FOV: 45 degrees; image size 2048x1536; retinal fundus photograph
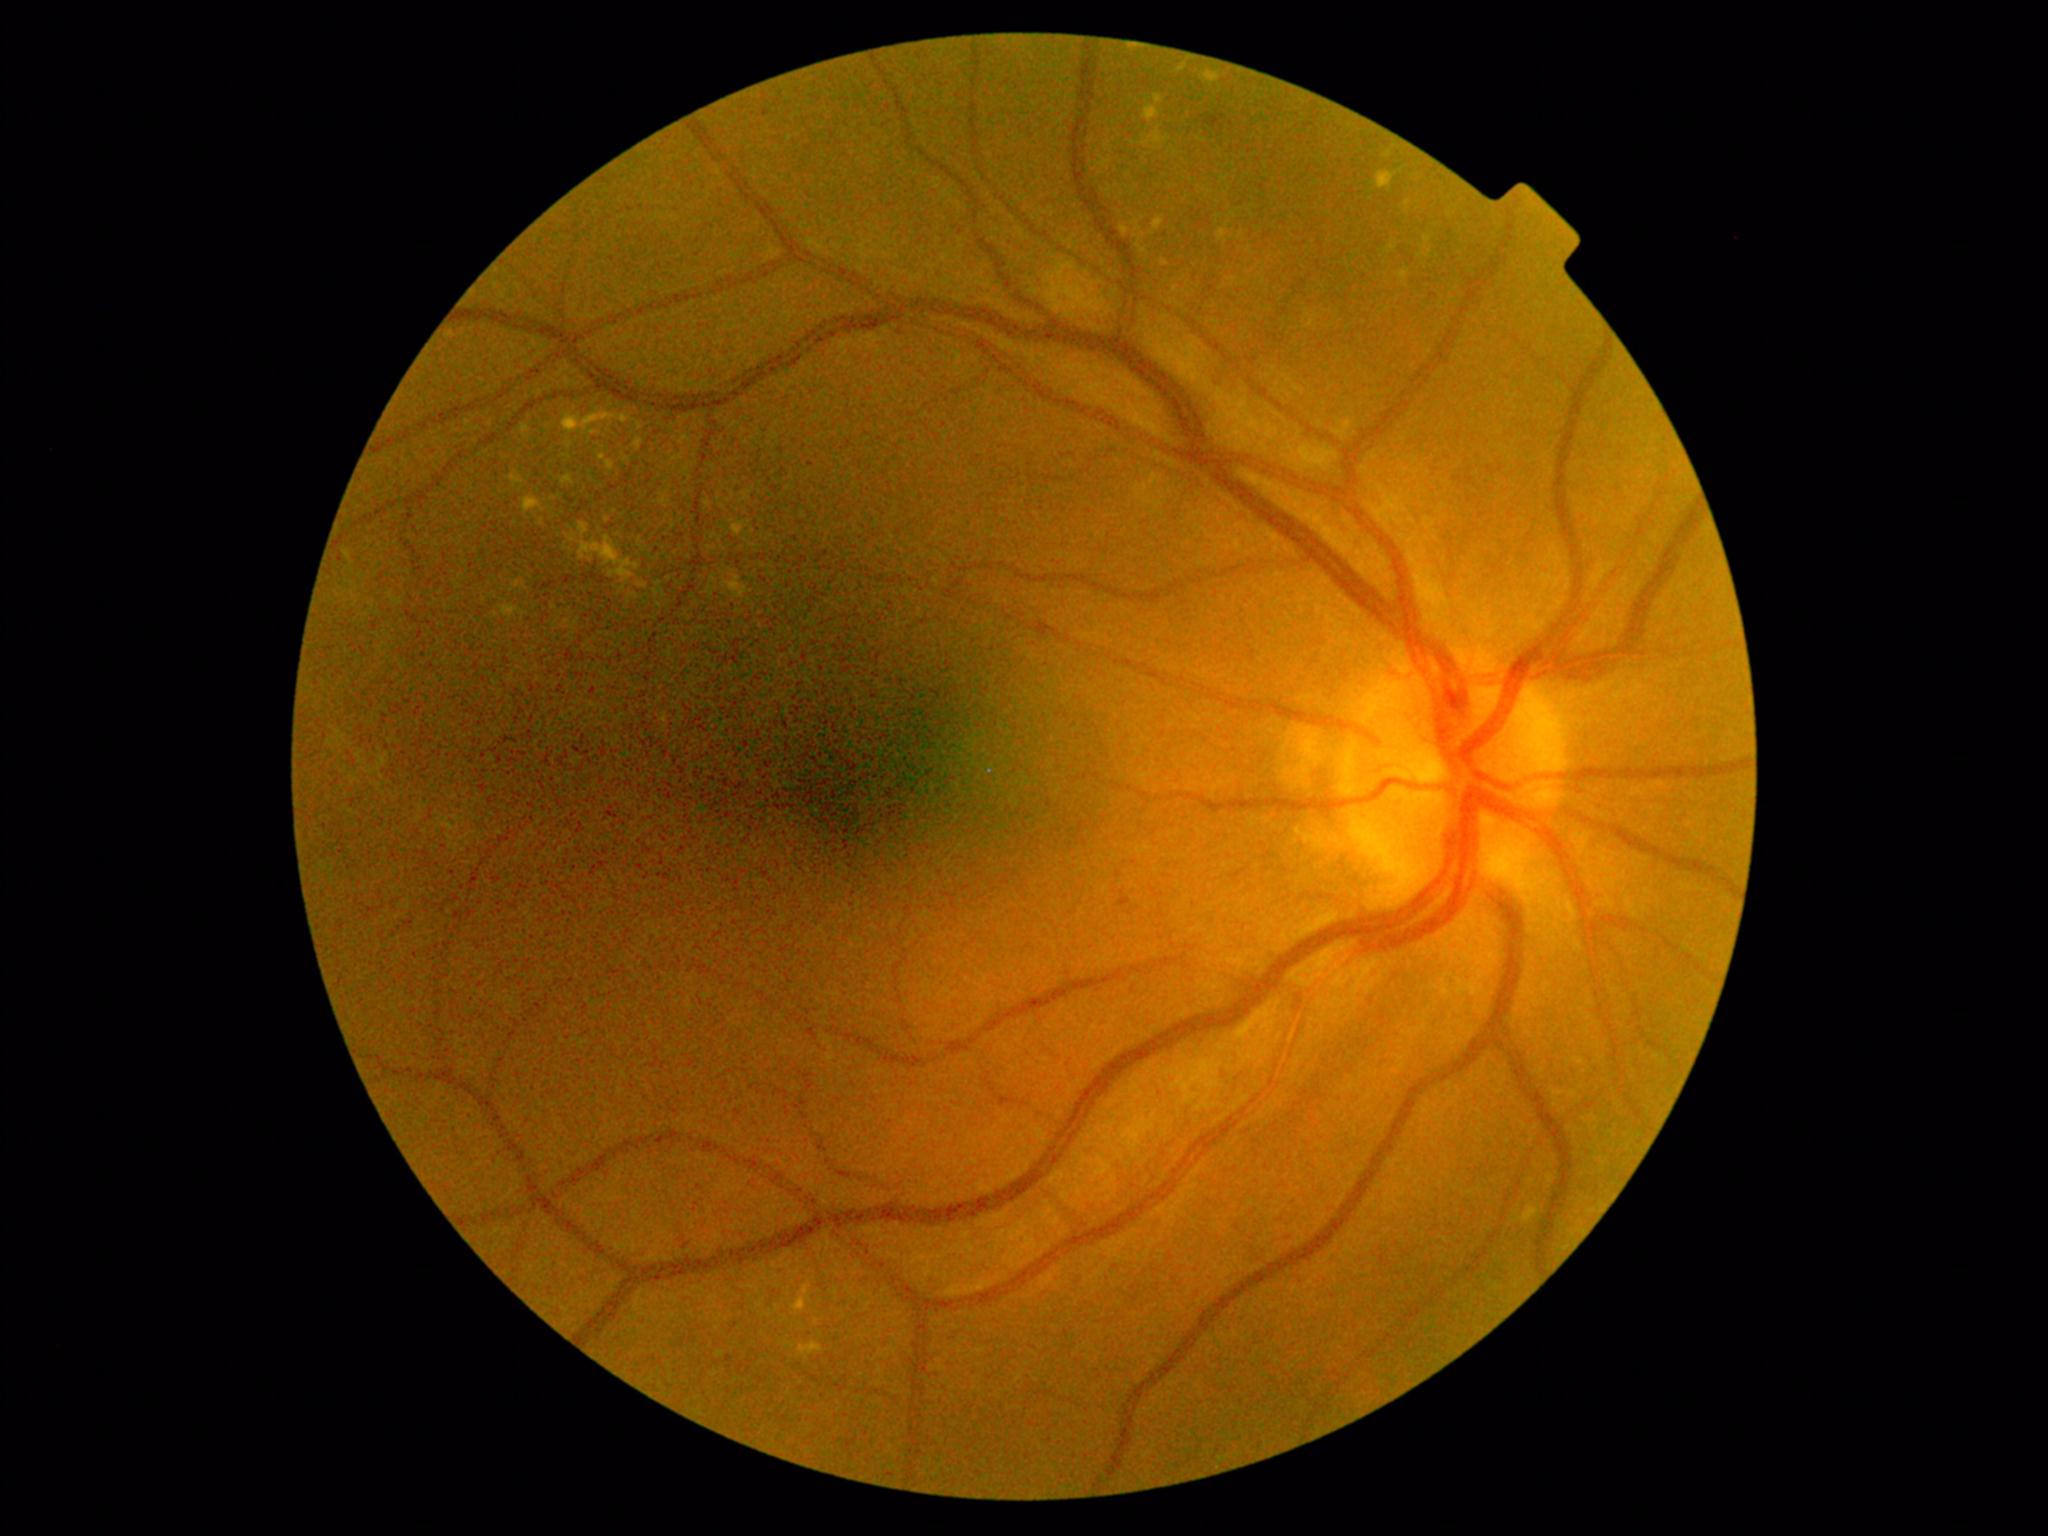 Diabetic retinopathy severity: moderate NPDR (grade 2)
Selected lesions:
* hard exudates (partial): bbox(1120, 225, 1130, 238); bbox(522, 496, 546, 515); bbox(1155, 95, 1163, 105); bbox(731, 520, 751, 536); bbox(519, 424, 532, 440); bbox(561, 475, 575, 486); bbox(704, 499, 713, 510); bbox(538, 518, 545, 526); bbox(792, 1283, 812, 1315); bbox(566, 522, 642, 595); bbox(1202, 70, 1221, 86)
* Smaller hard exudates around <pt>554,499</pt>; <pt>602,448</pt>; <pt>1421,256</pt>
* microaneurysms: bbox(763, 109, 770, 118); bbox(1118, 889, 1132, 908)
* hemorrhages: bbox(1201, 116, 1228, 131)
* soft exudates: none